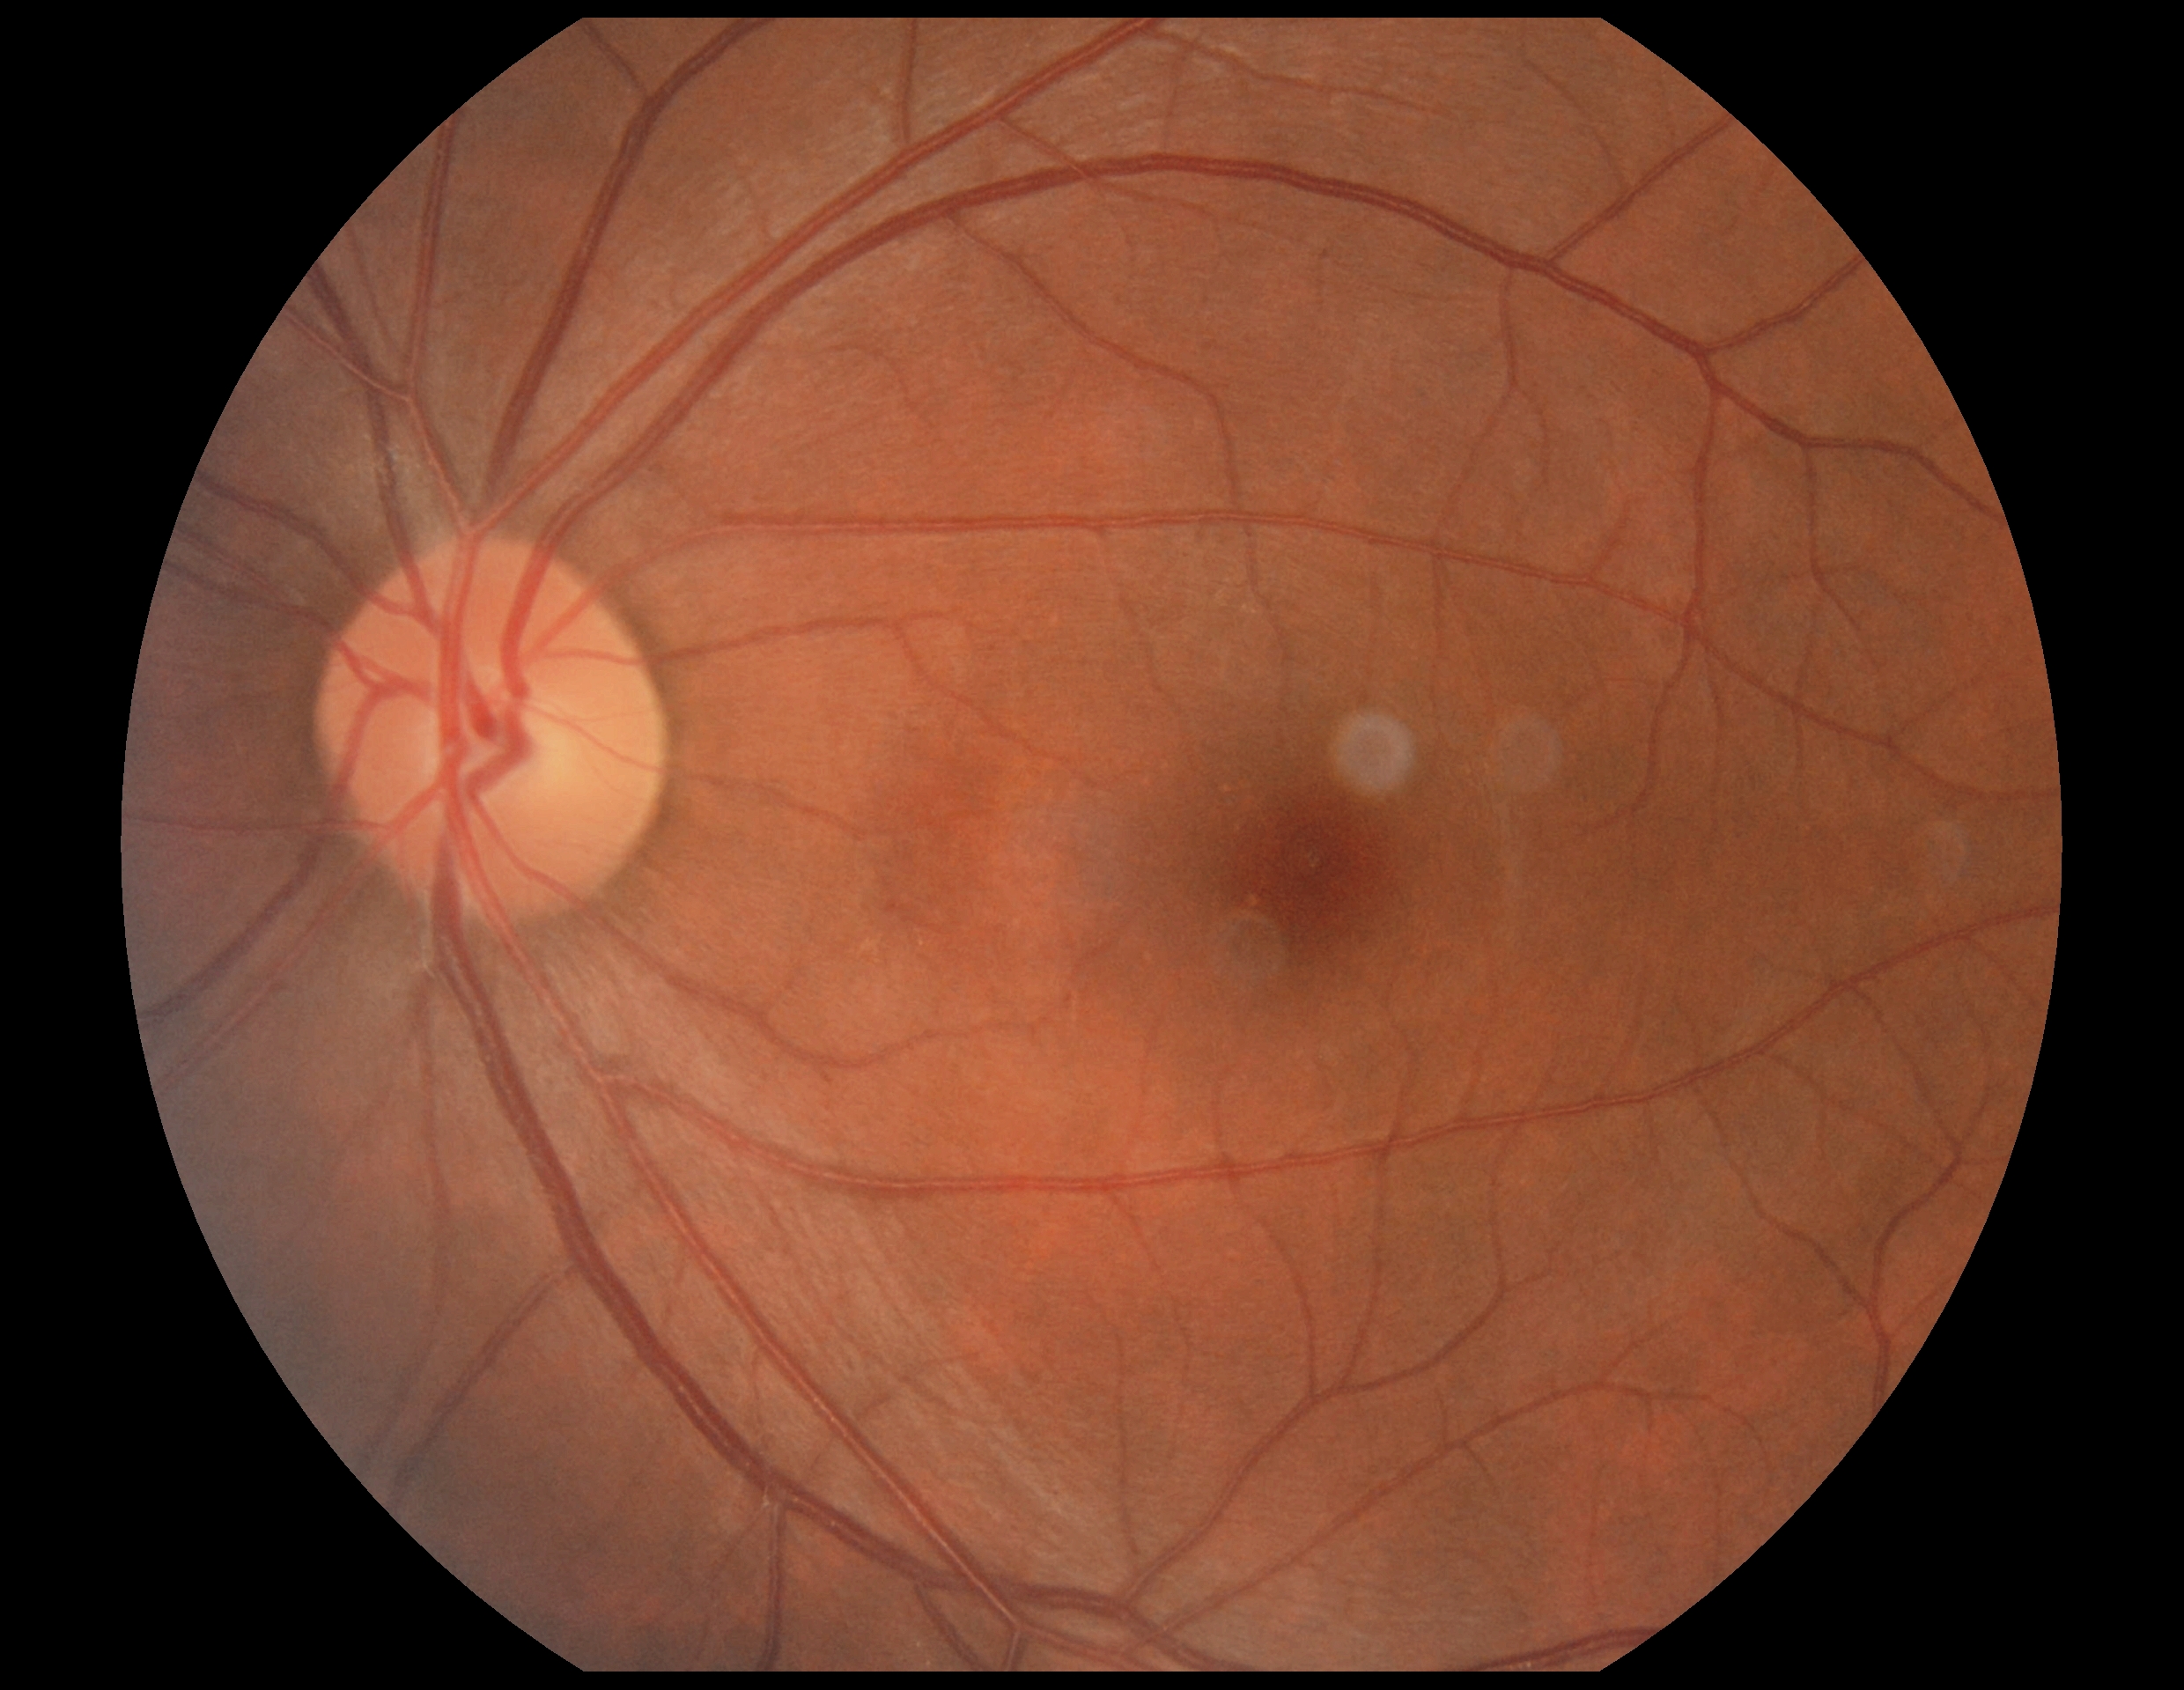 Retinopathy grade: no apparent retinopathy (0) — no visible signs of diabetic retinopathy.